1932 x 1932 pixels; 45° FOV: 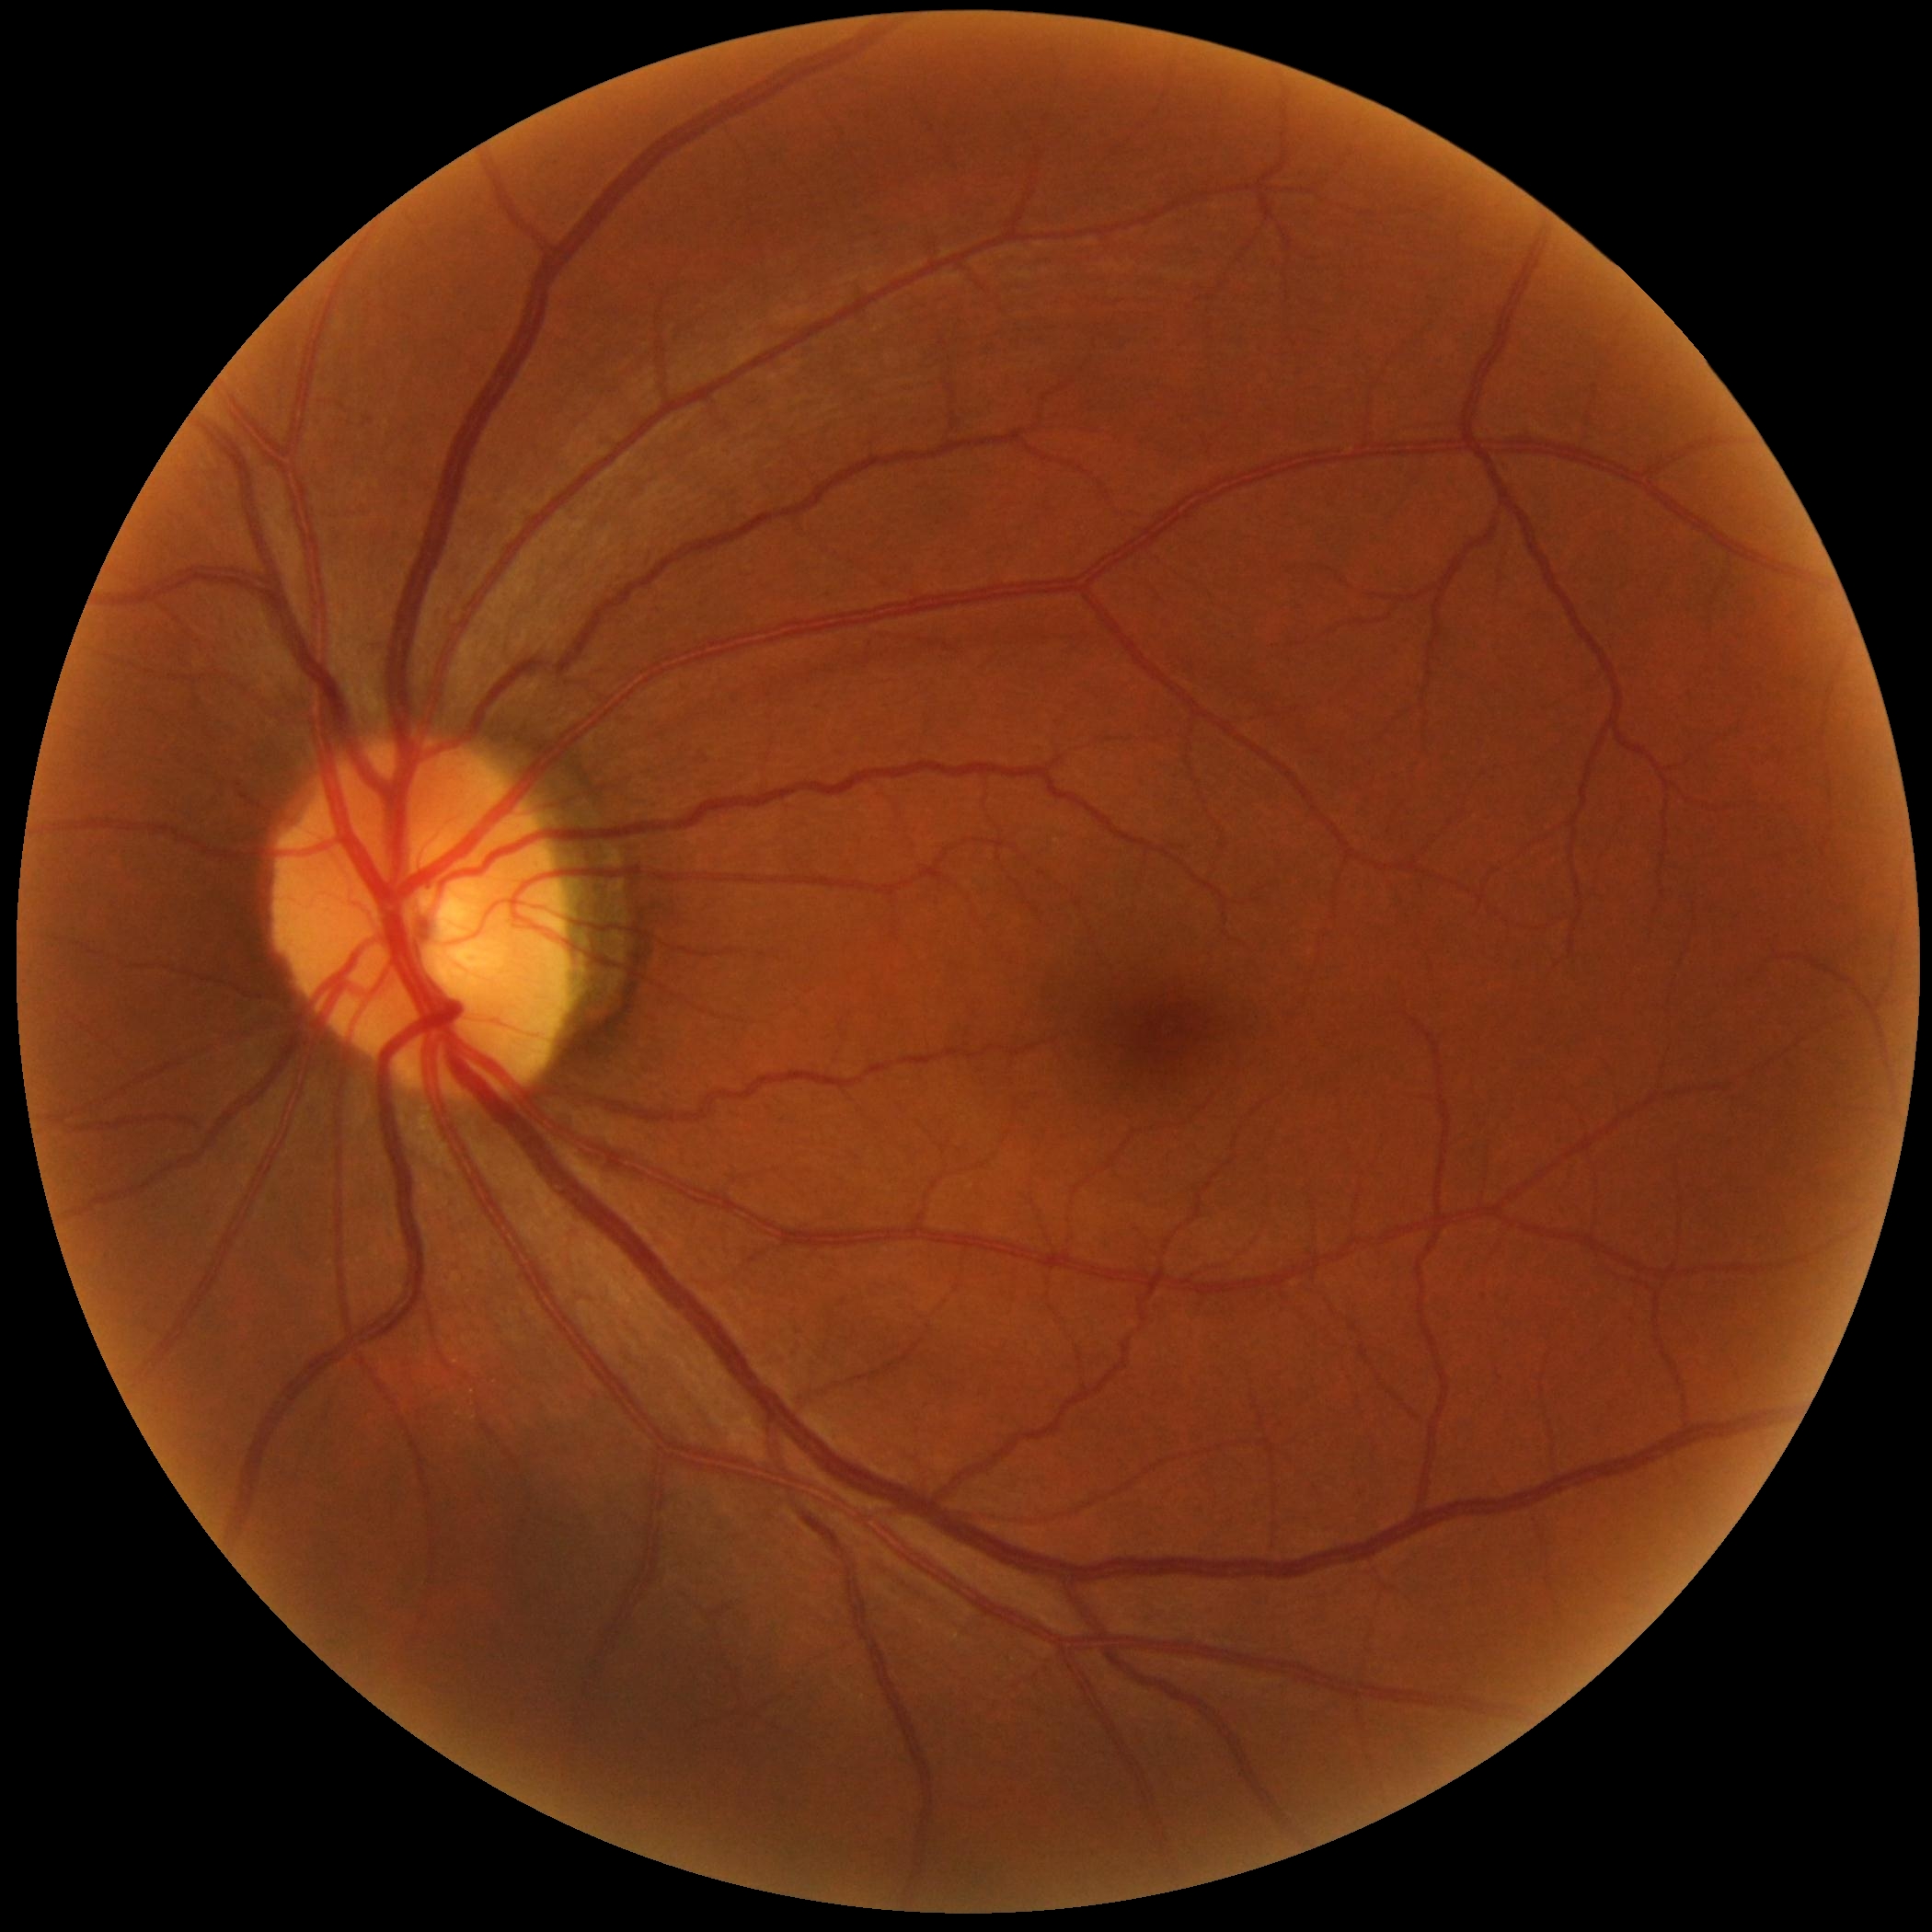

DR: grade 0 (no apparent retinopathy) — no visible signs of diabetic retinopathy.